45° field of view. Graded on the modified Davis scale:
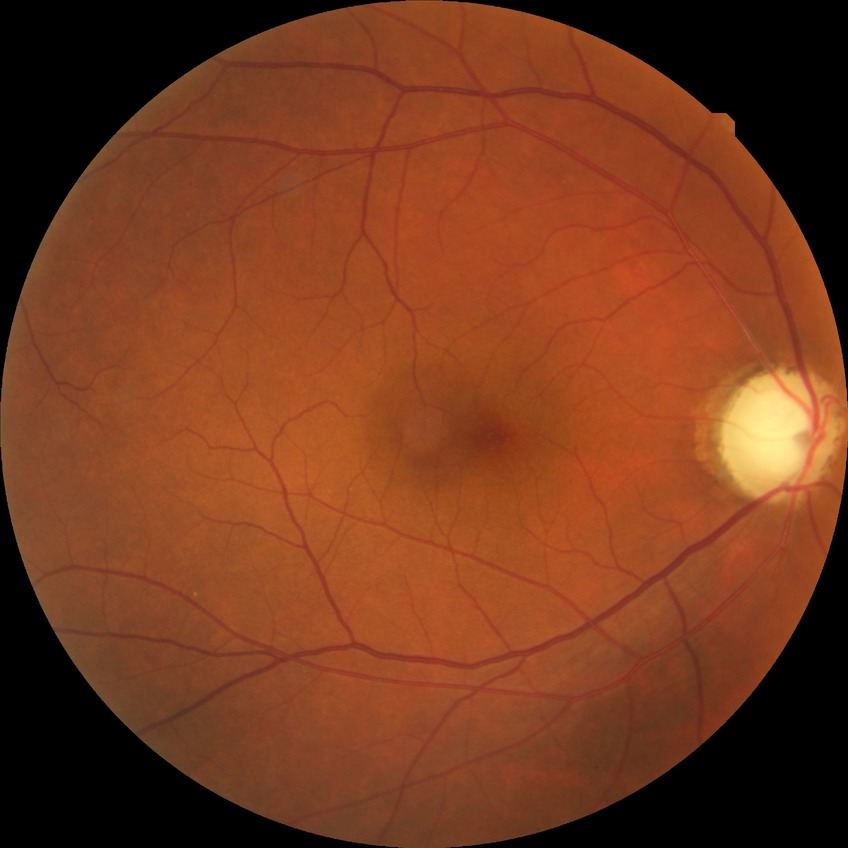 * modified Davis grade: NDR